848x848 · DR severity per modified Davis staging: 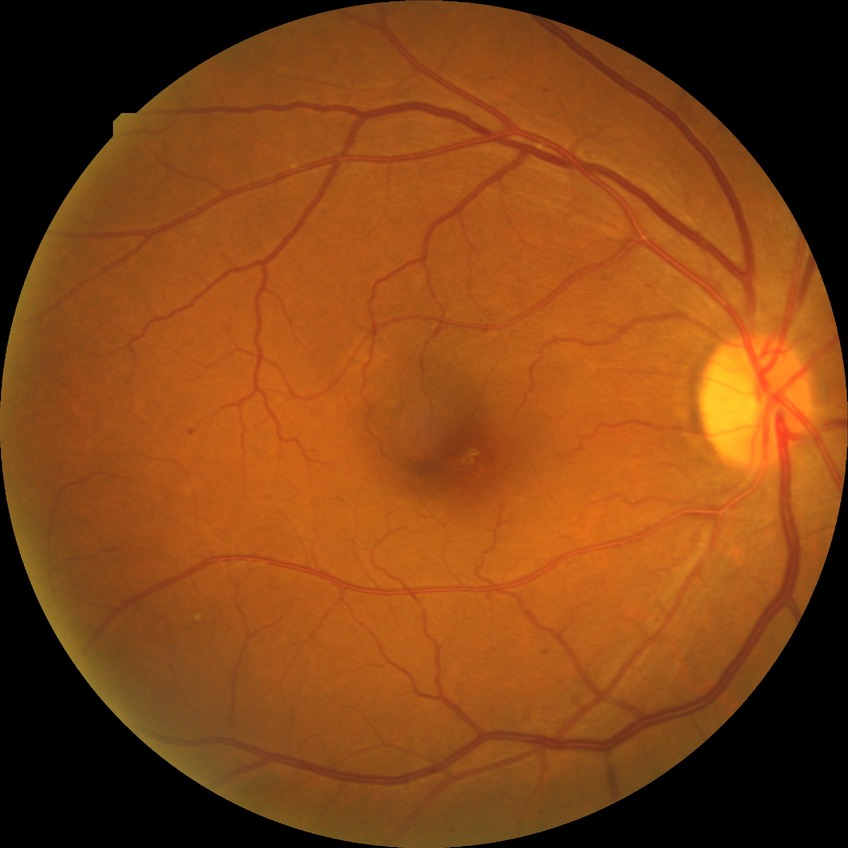
Diabetic retinopathy (DR) is pre-proliferative diabetic retinopathy (PPDR).